Wide-field contact fundus photograph of an infant · 100° field of view (Phoenix ICON)
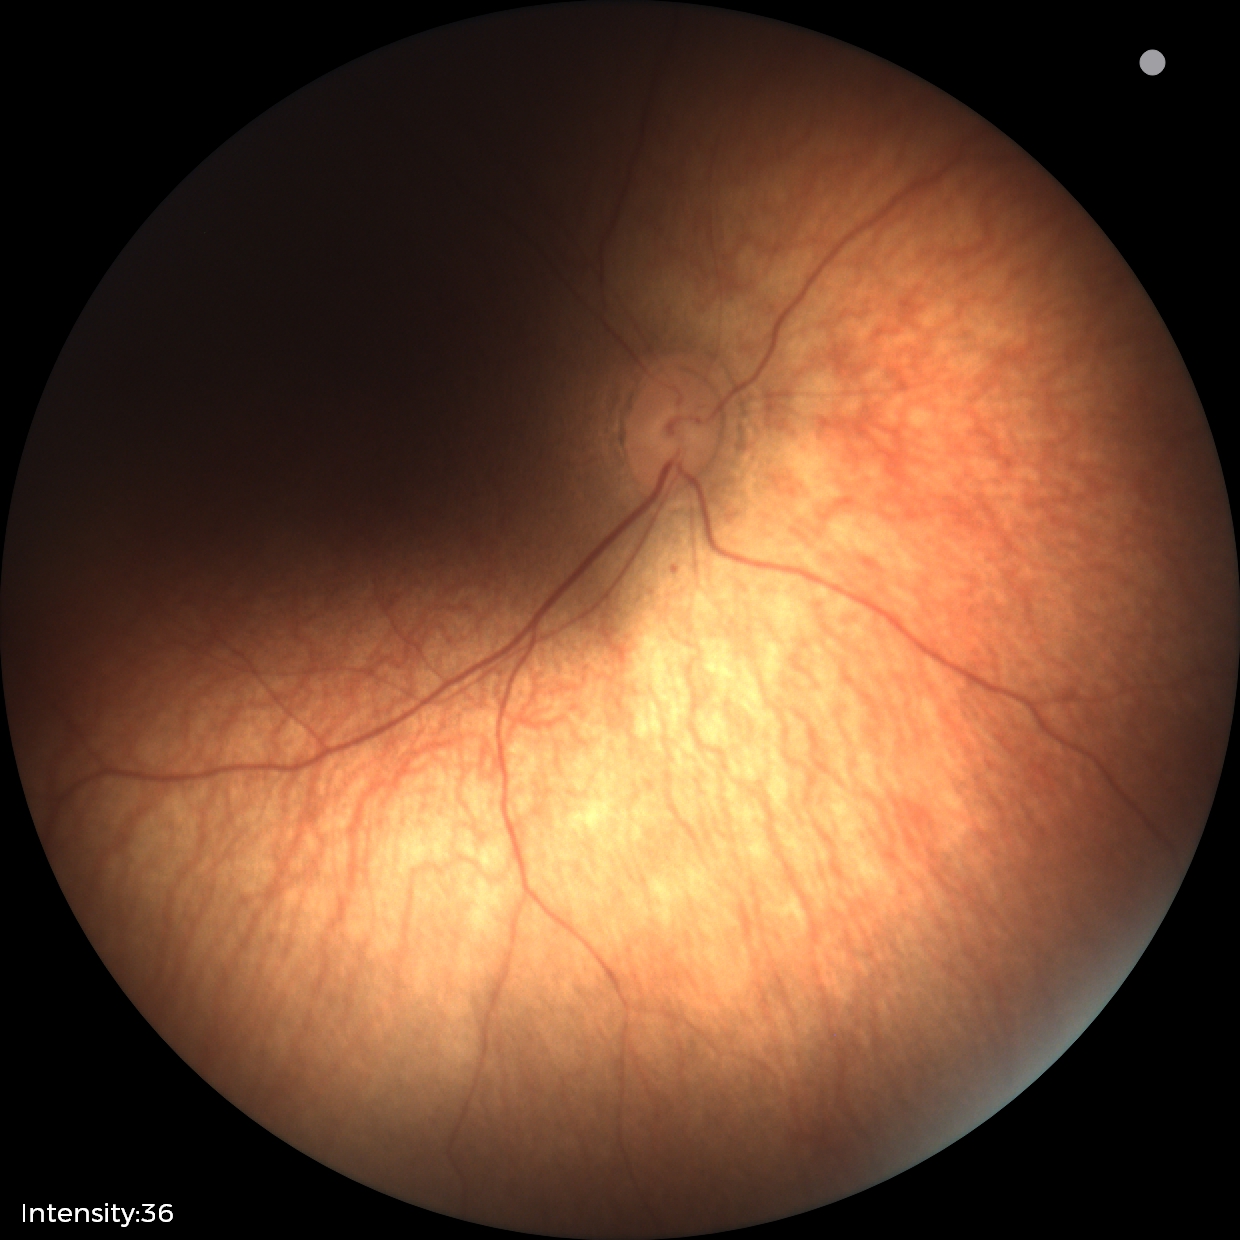

Diagnosis = physiological appearance.